Portable fundus photograph.
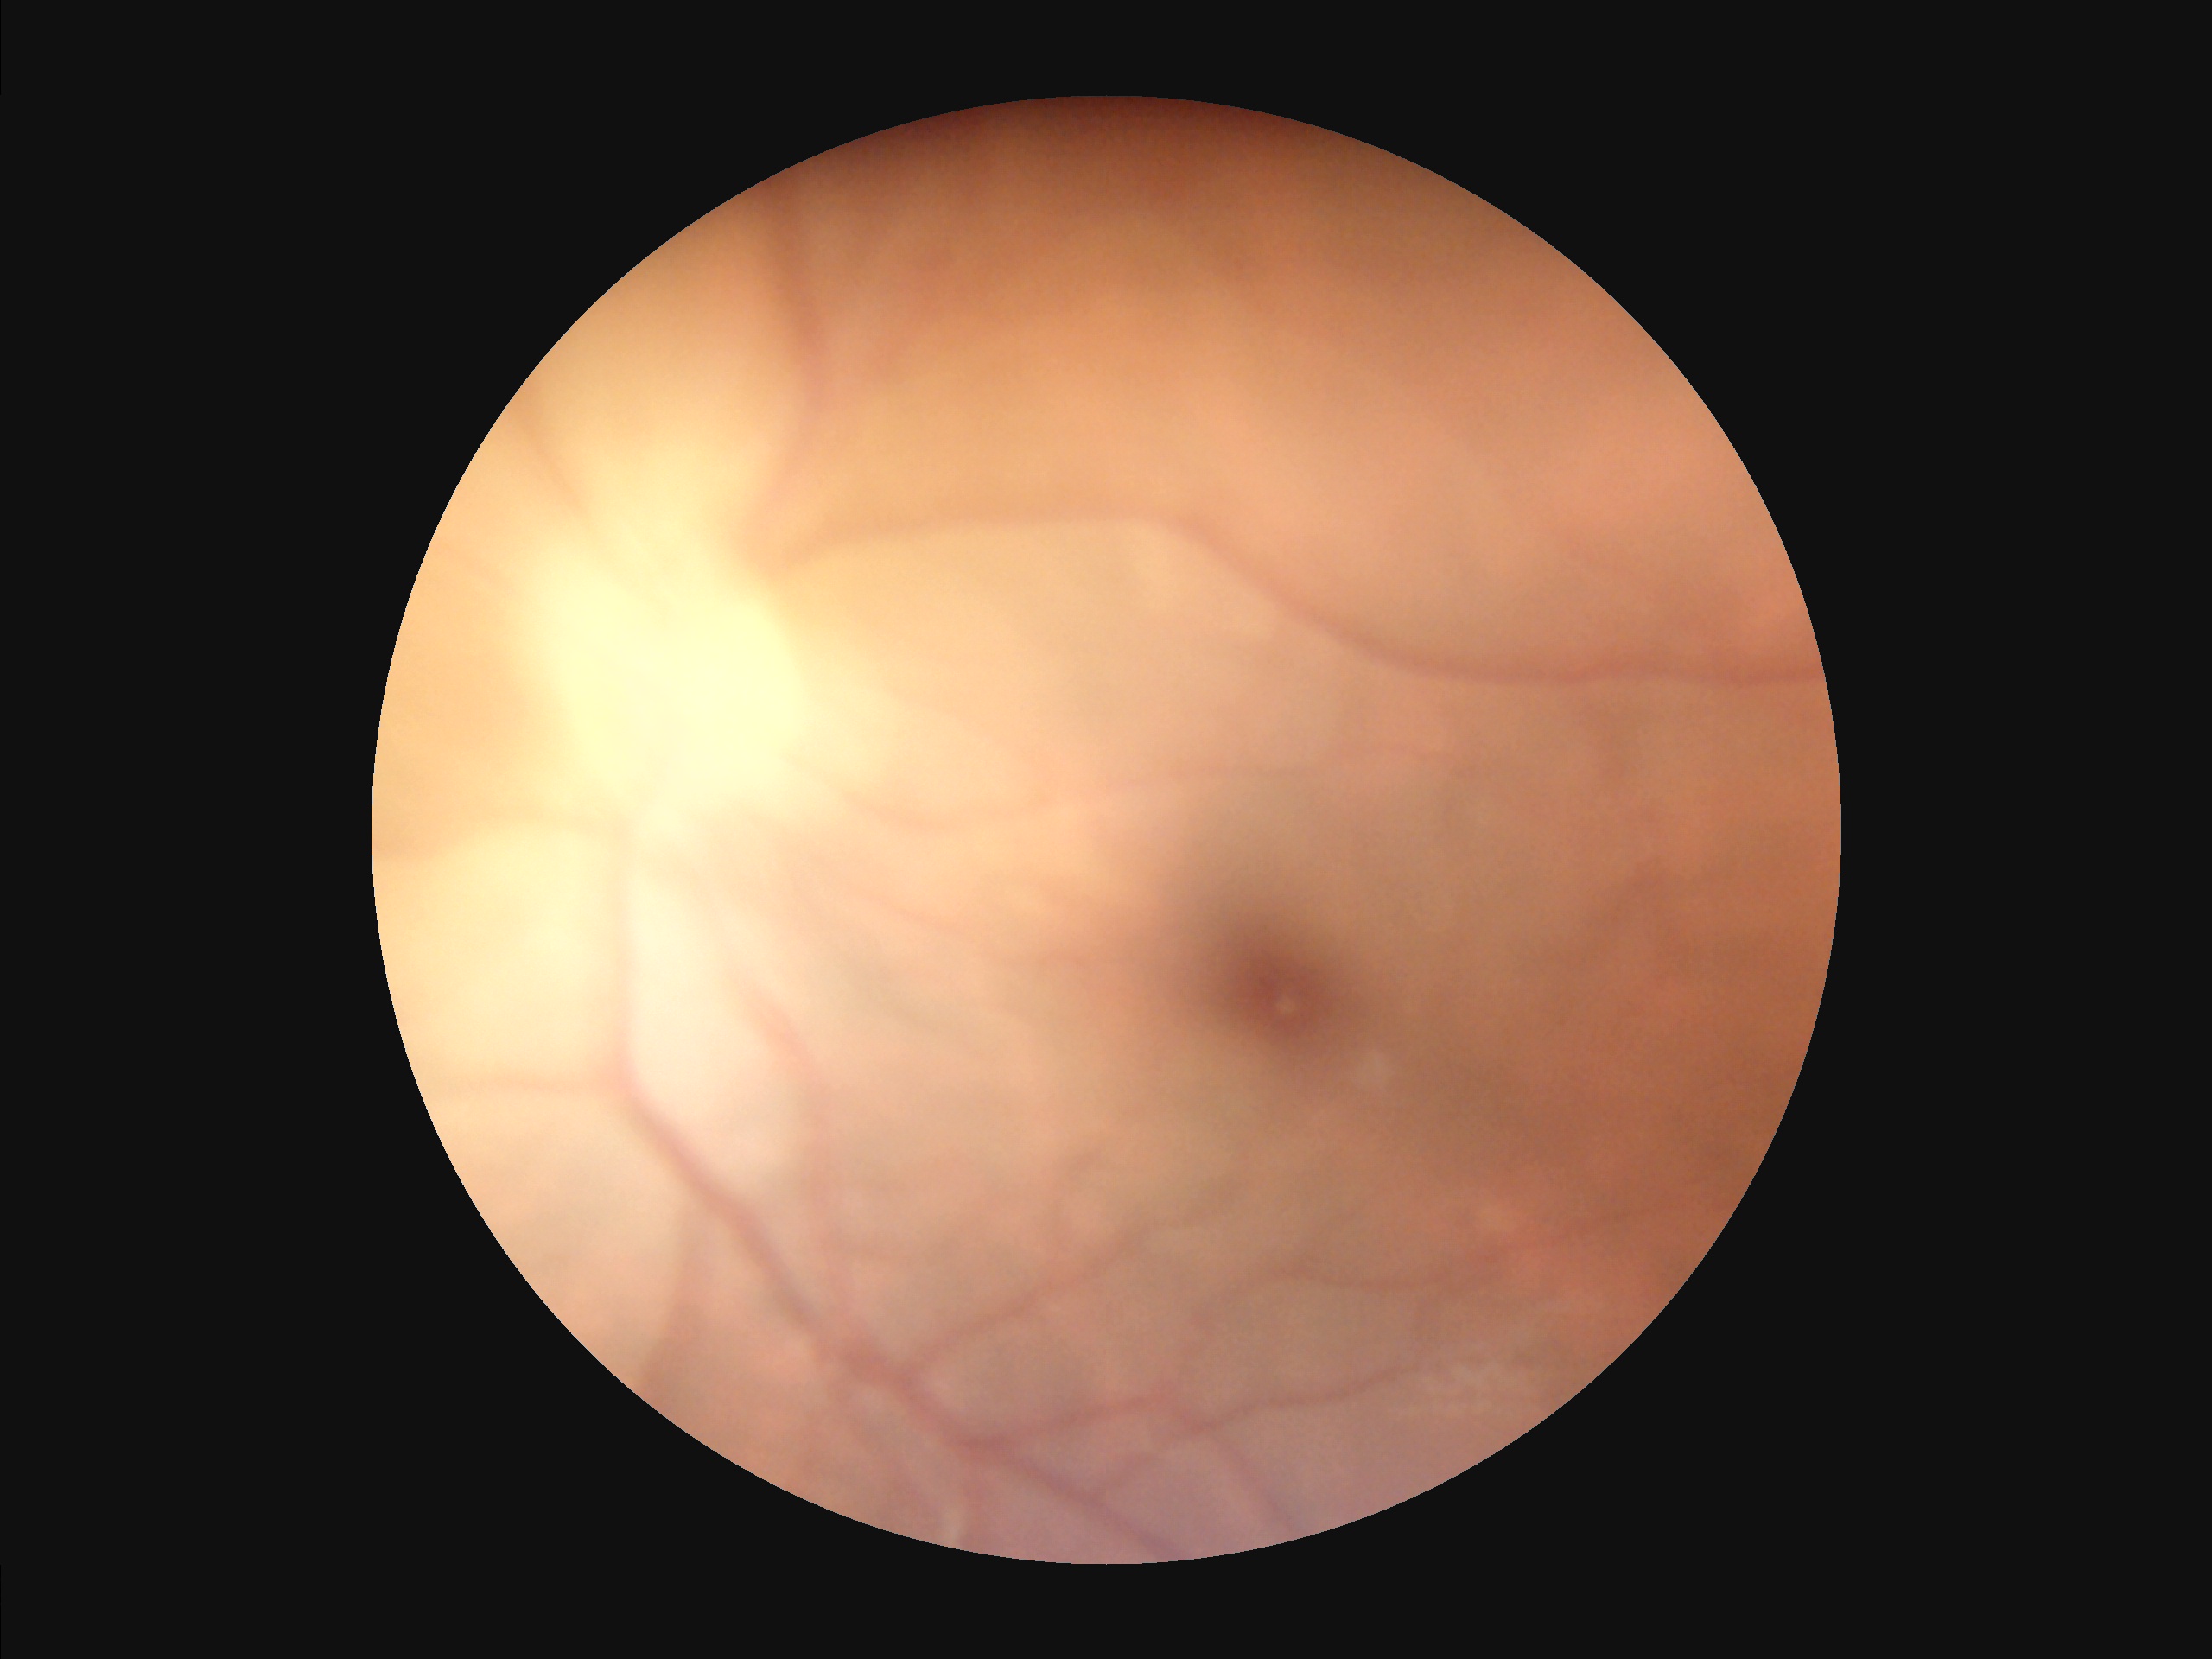
Poor dynamic range. Illumination and color balance are good. Out of focus; structures are indistinct. Image quality is inadequate for diagnostic use.